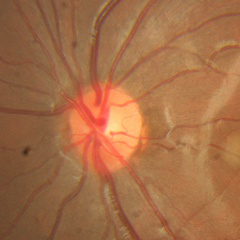
Demonstrates no signs of glaucoma.